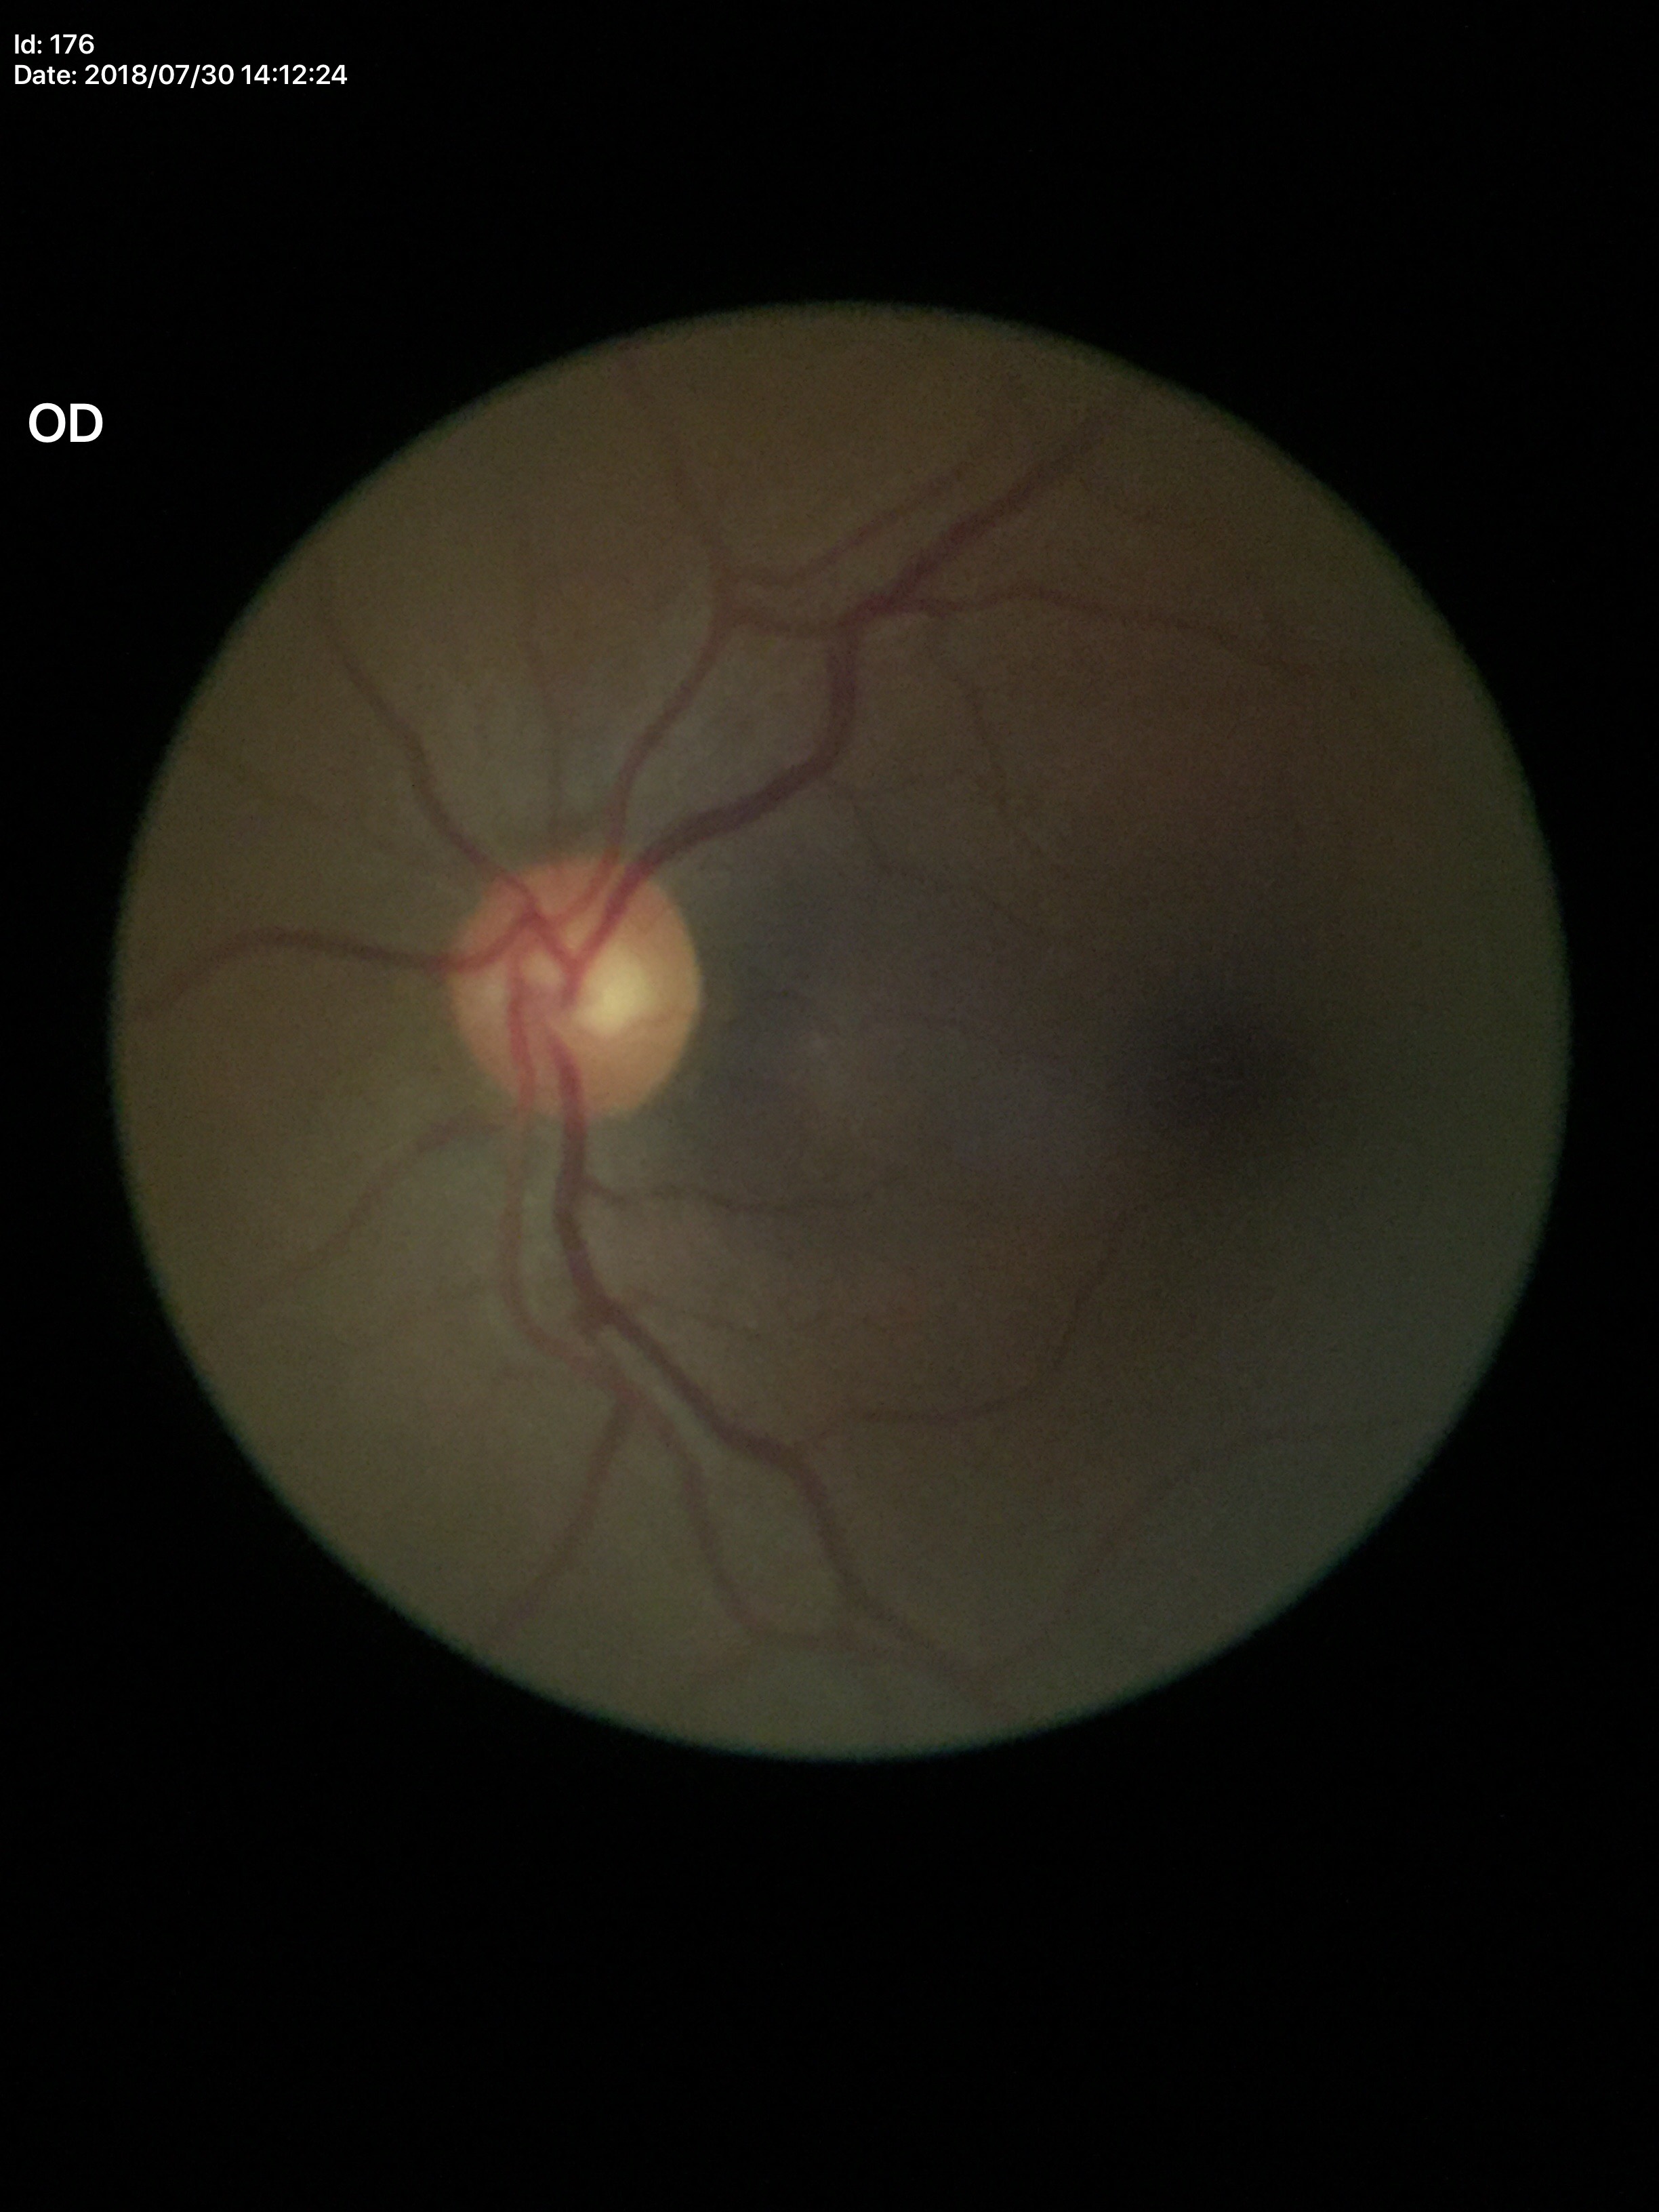

Glaucoma impression: no suspicious findings. Vertical cup-disc ratio (VCDR) is 0.53.